Fundus photo.
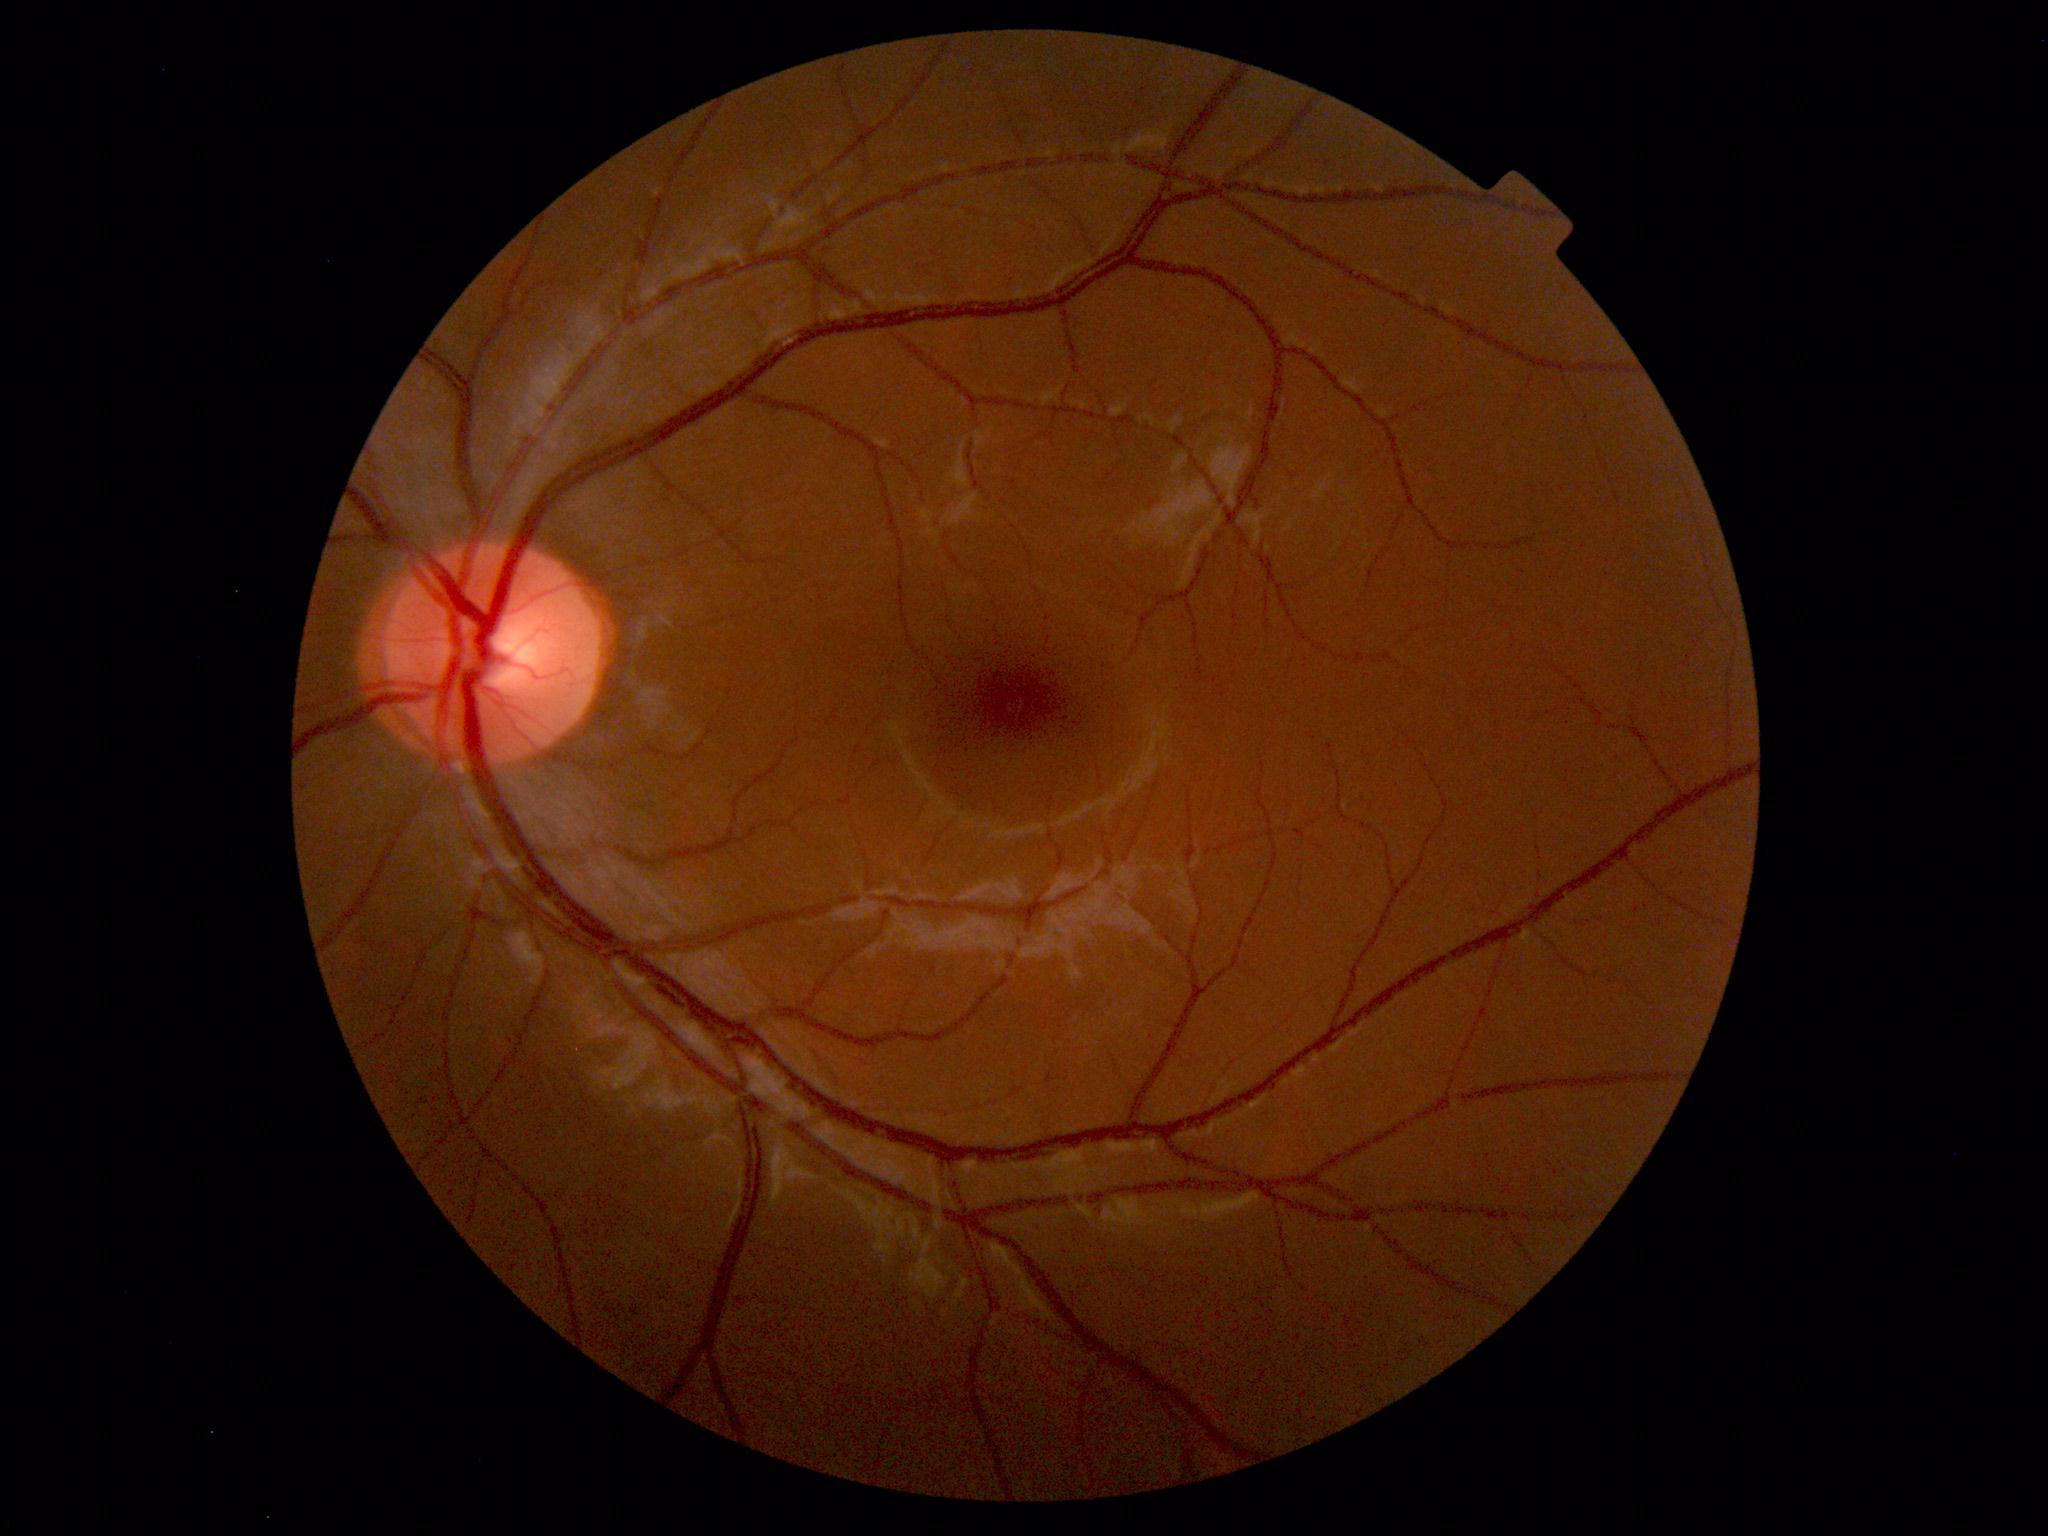 No abnormal findings on fundus examination.